DR severity per modified Davis staging, nonmydriatic, 848 by 848 pixels
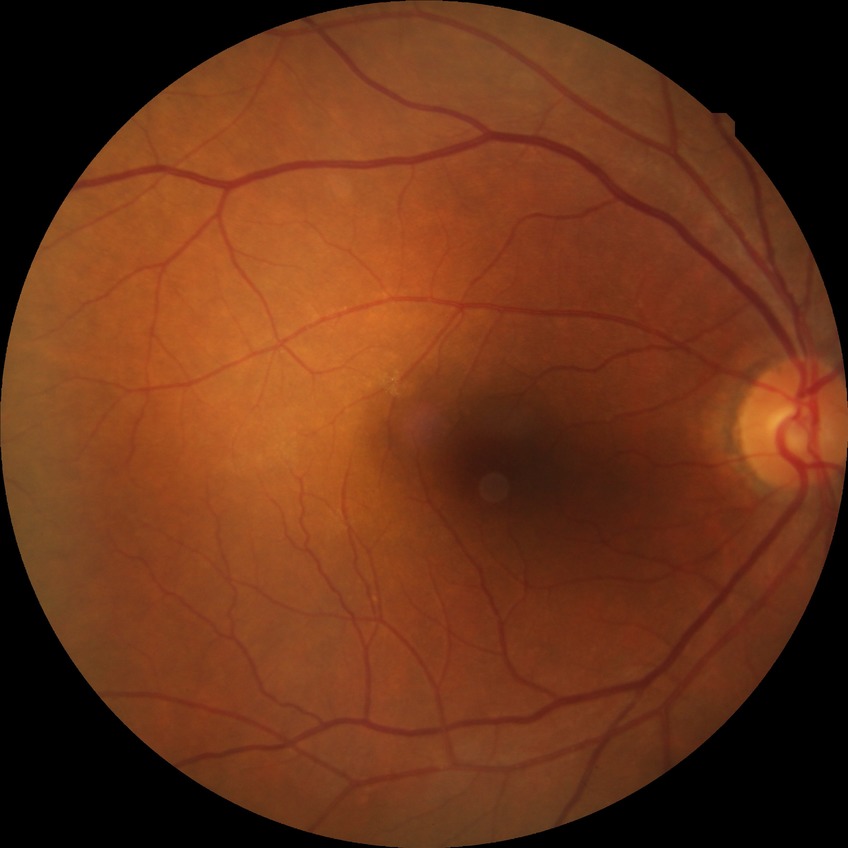
diabetic retinopathy (DR)=NDR (no diabetic retinopathy).